Camera: Clarity RetCam 3 (130° FOV) · infant wide-field fundus photograph
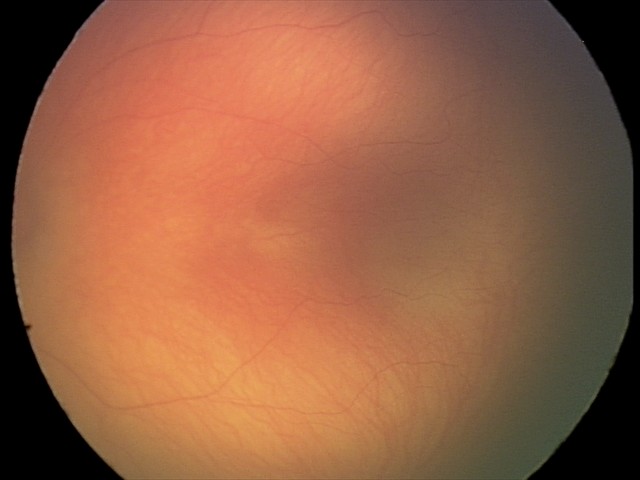

Series diagnosed as retinopathy of prematurity (ROP) stage 1.